2212x1659px · fundus photo
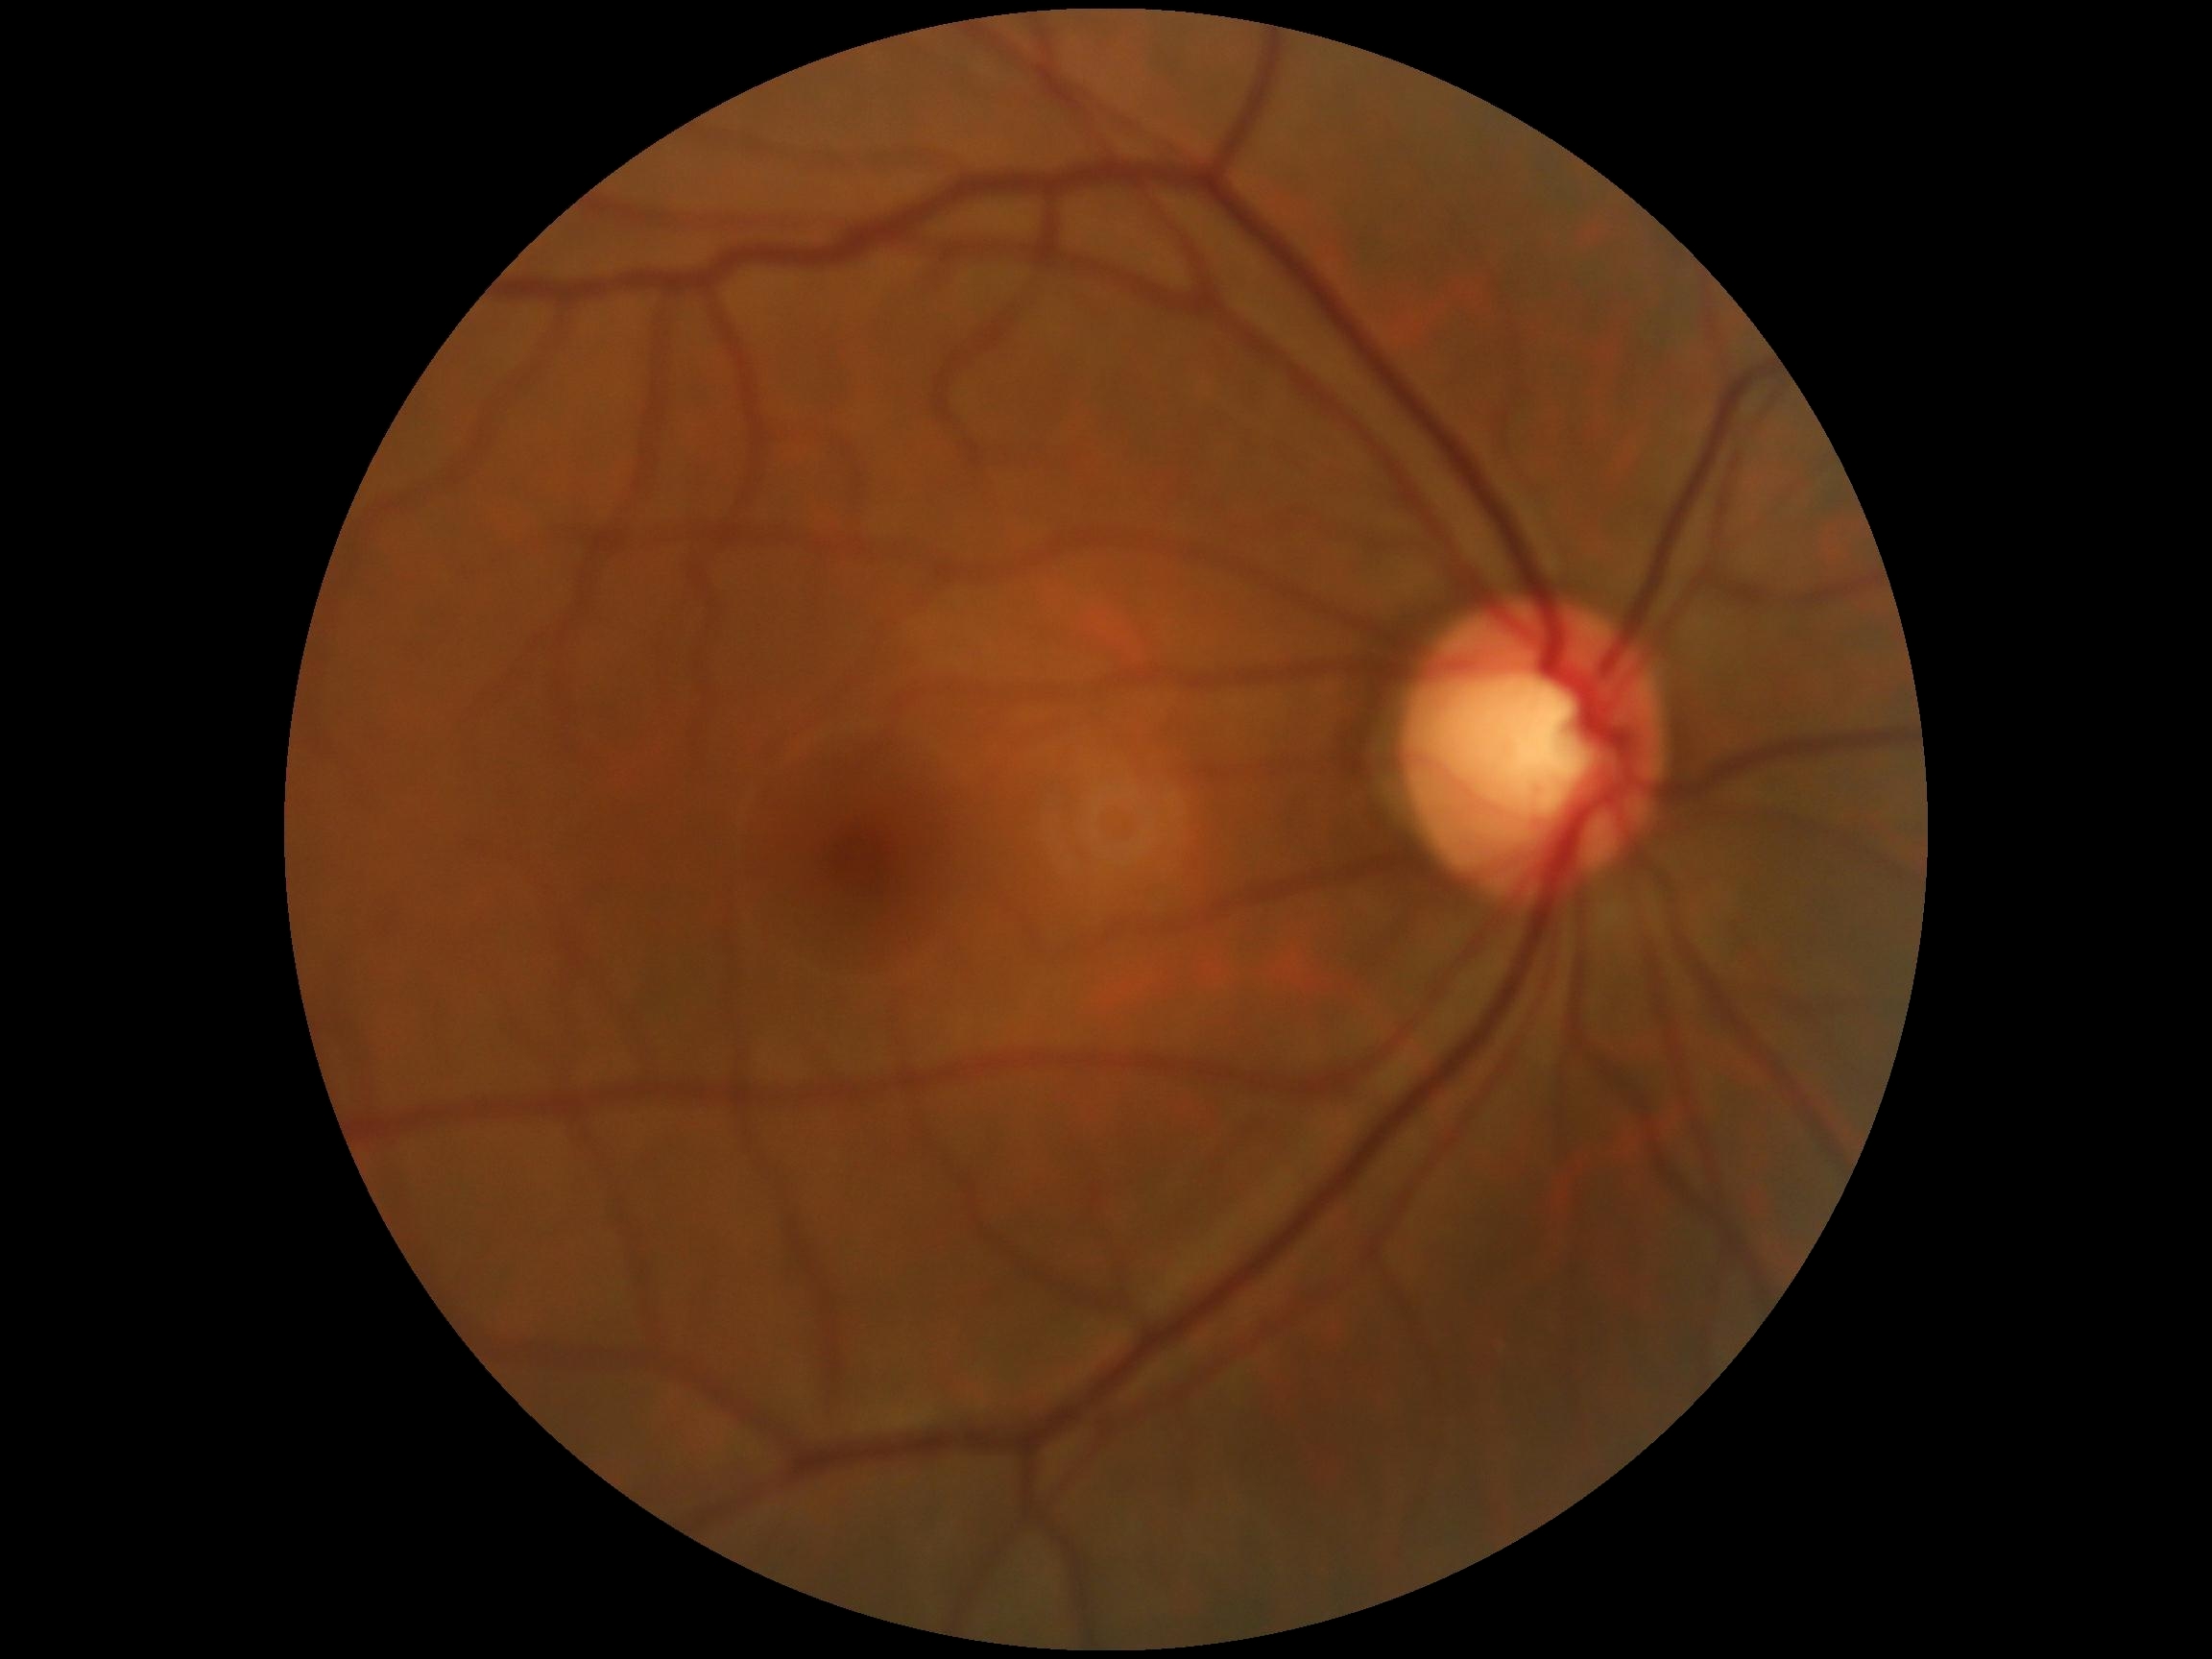
DR: grade 0. No DR findings.